Image size 2352x1568.
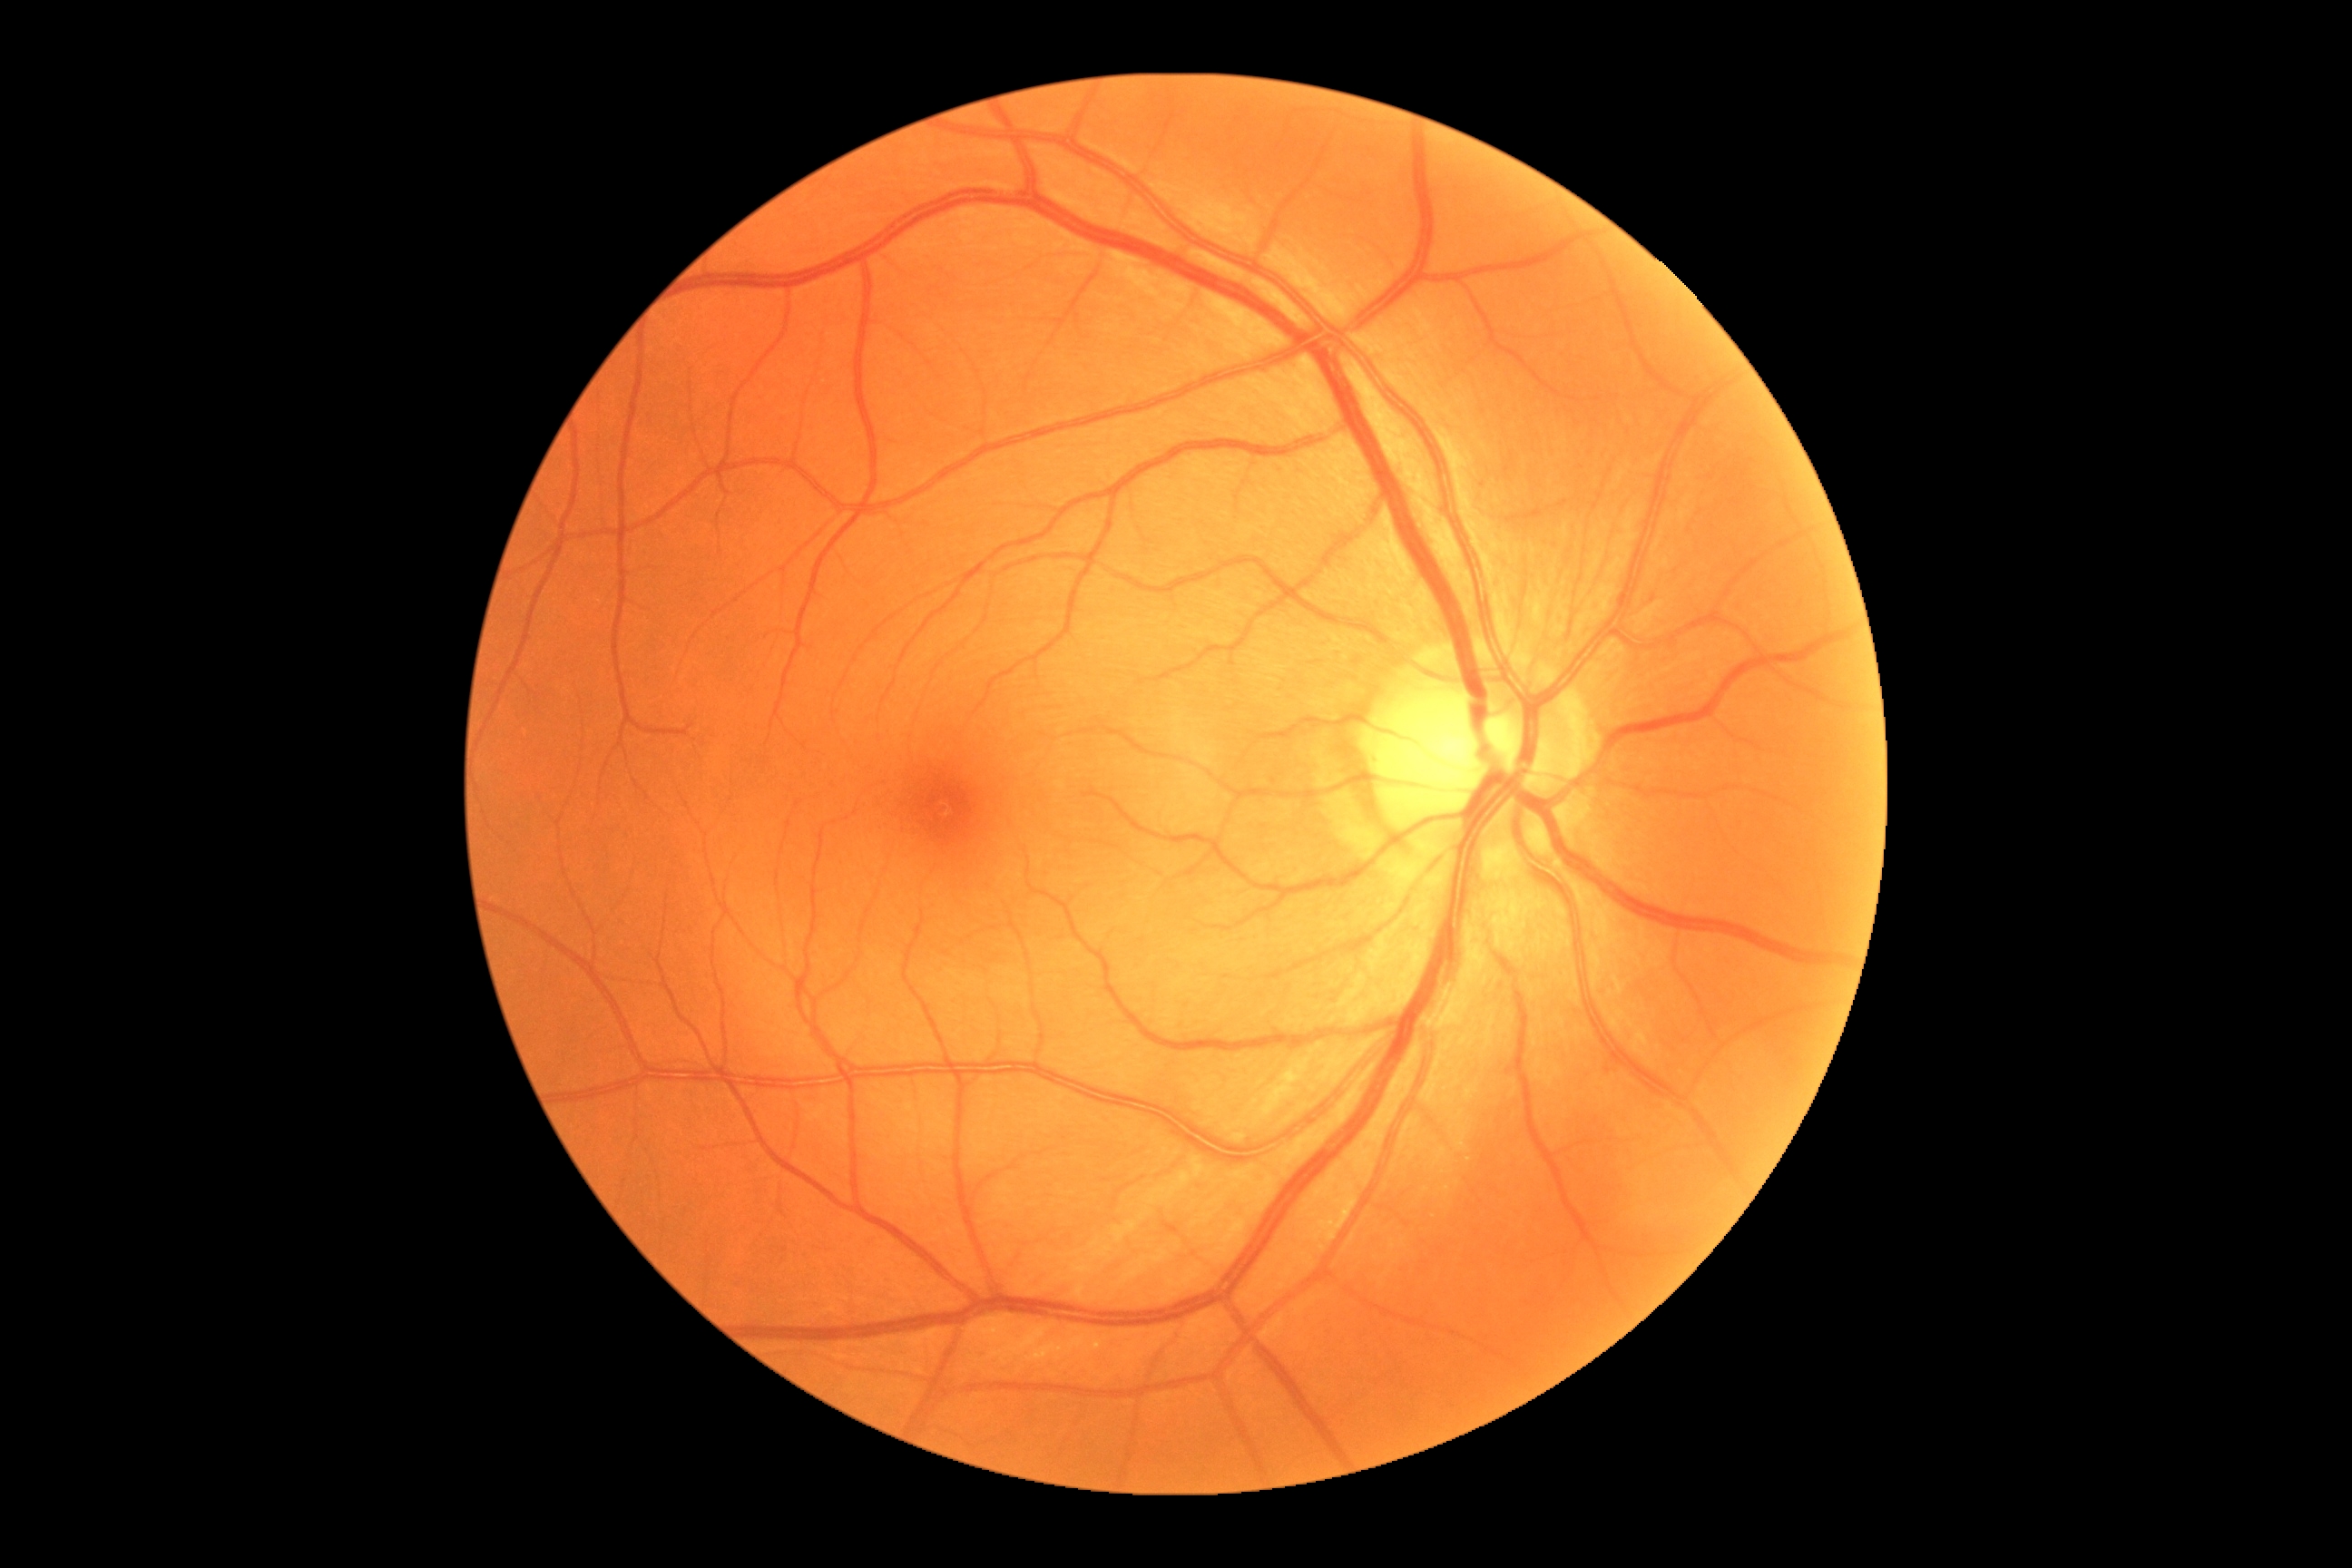

DR impression = no DR findings; retinopathy = grade 0 (no apparent retinopathy).